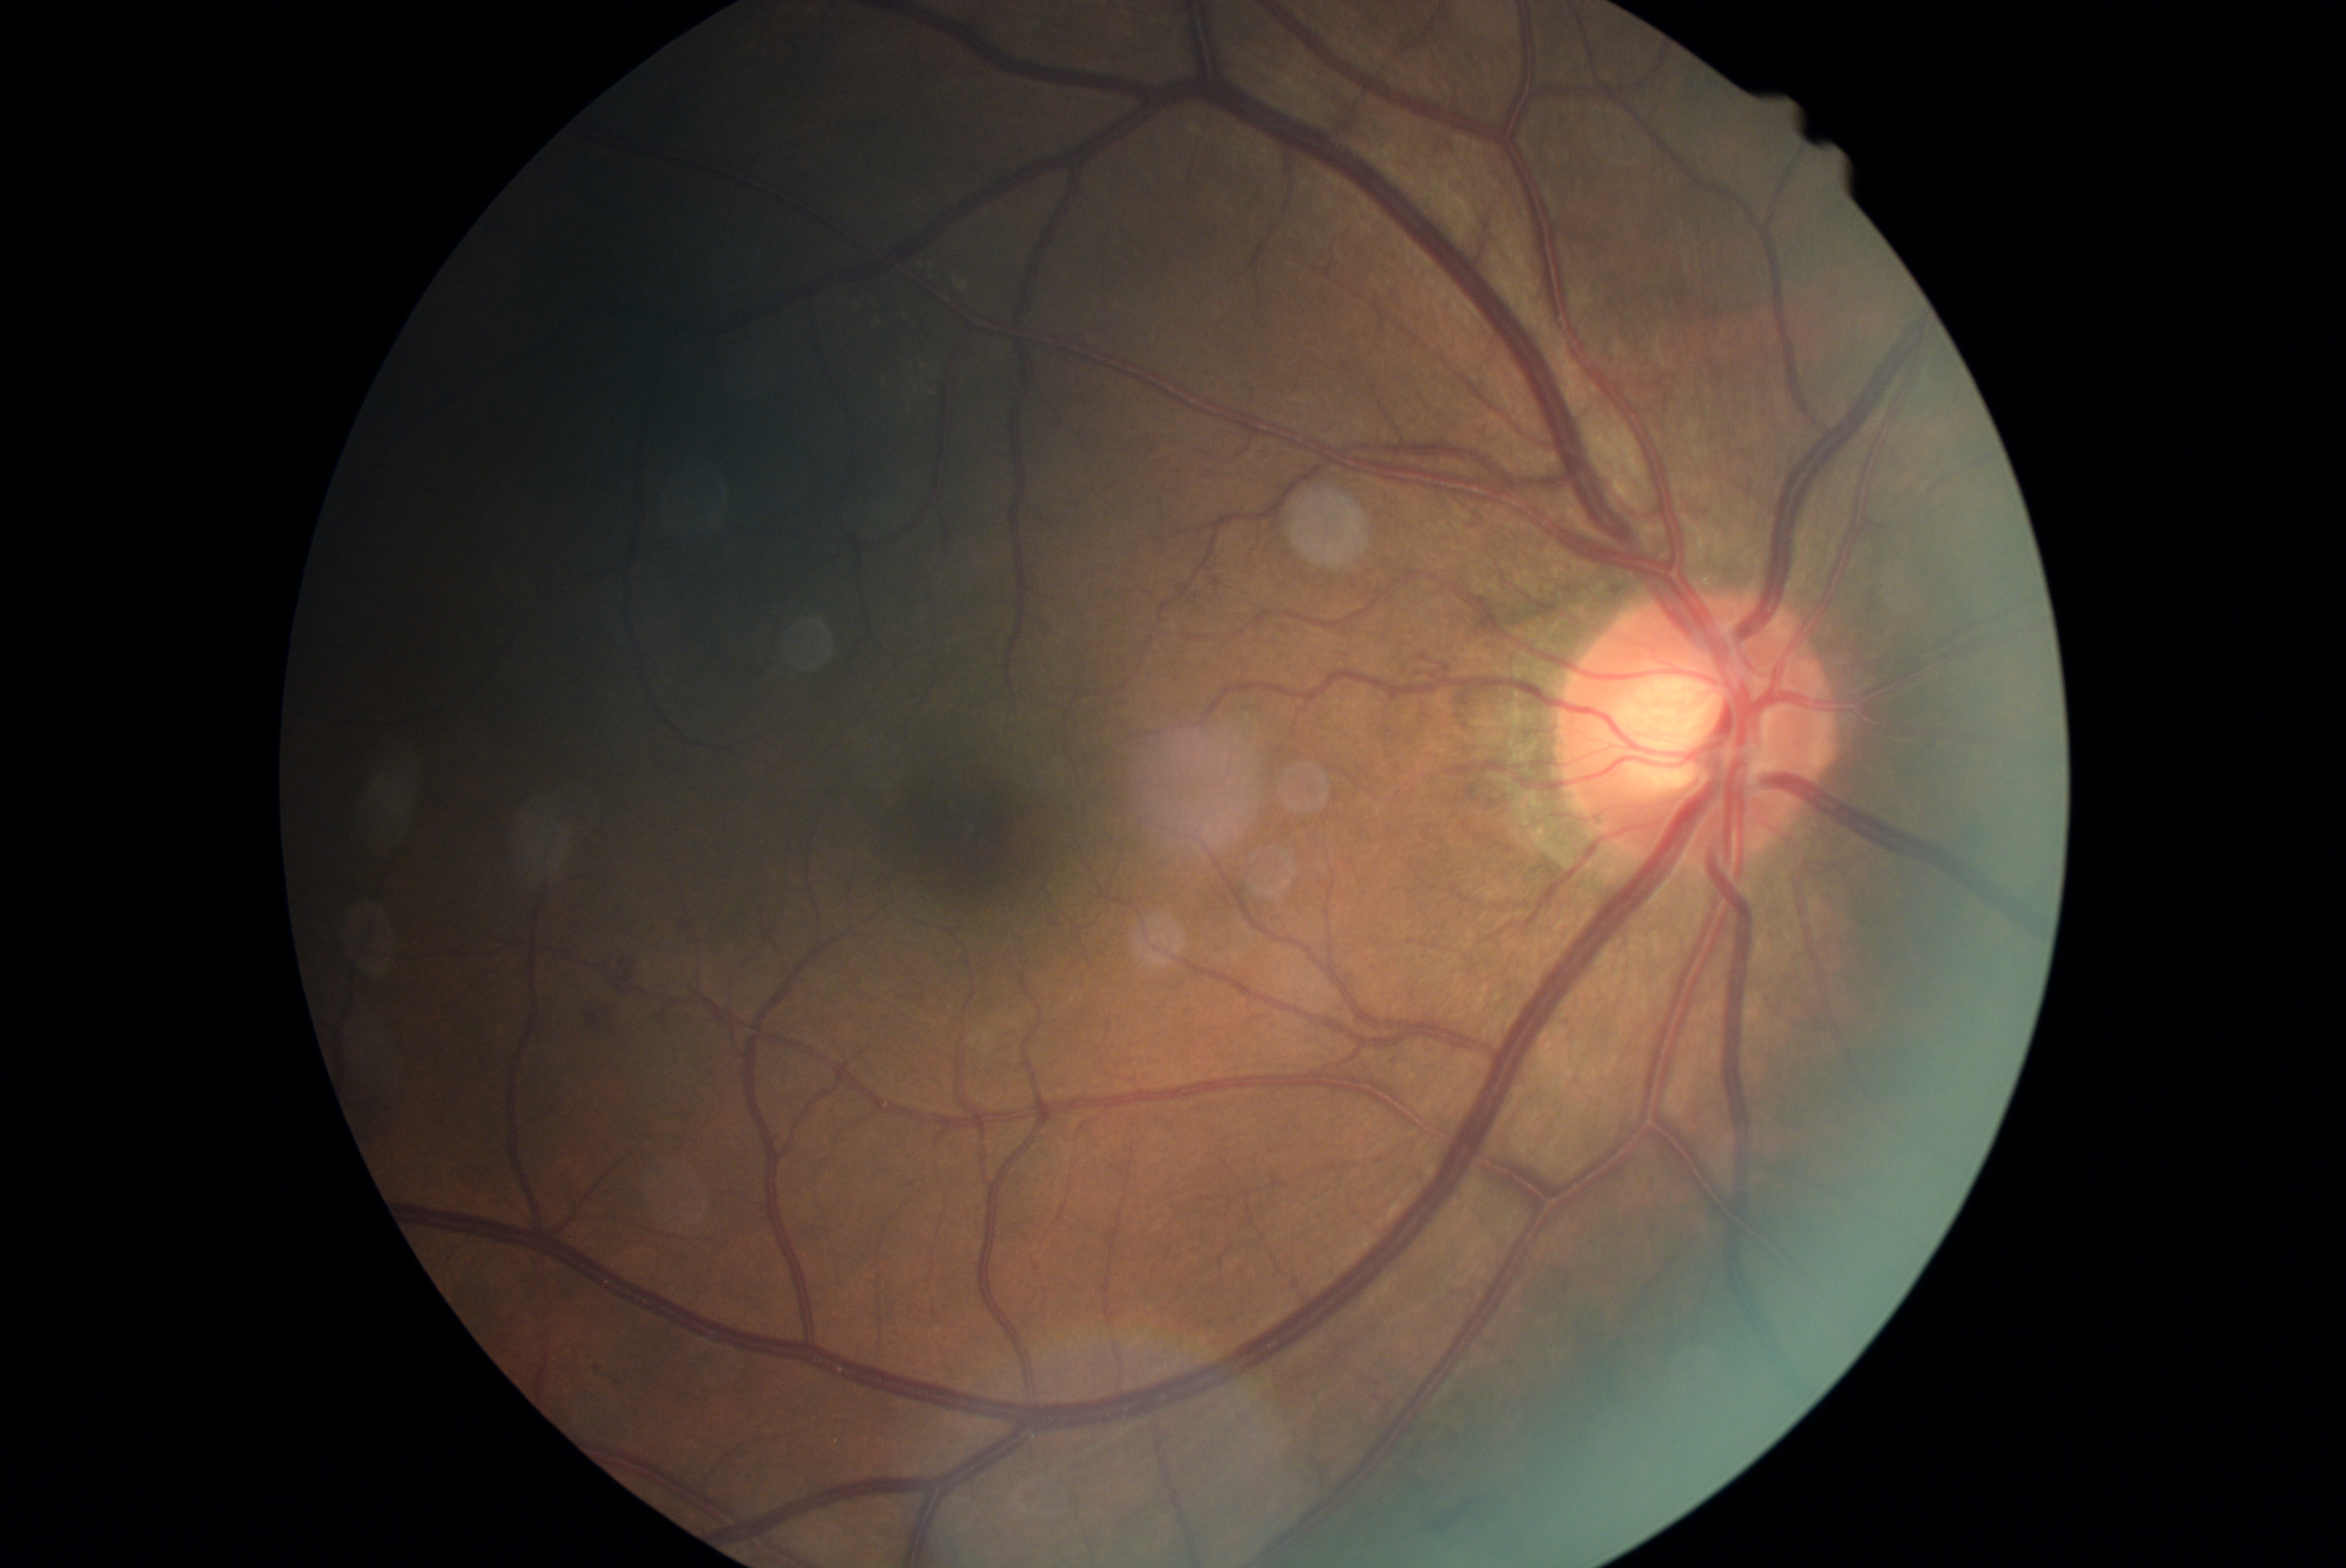
Disease class: non-proliferative diabetic retinopathy. DR severity is moderate NPDR (grade 2) — more than just microaneurysms but less than severe NPDR.